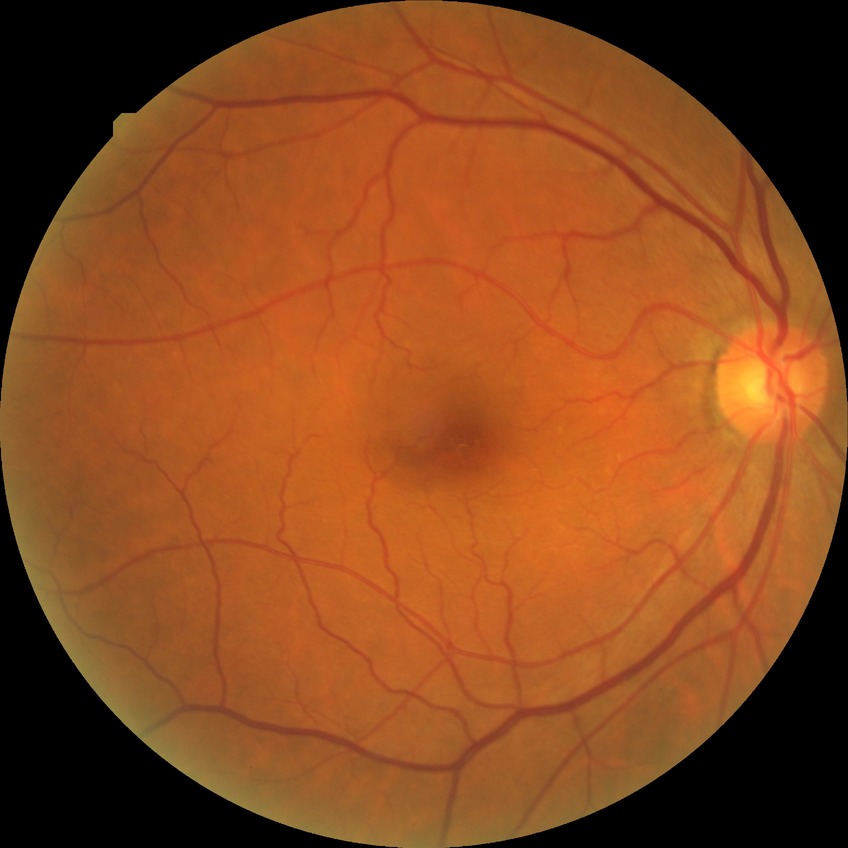 diabetic retinopathy grade: no diabetic retinopathy.